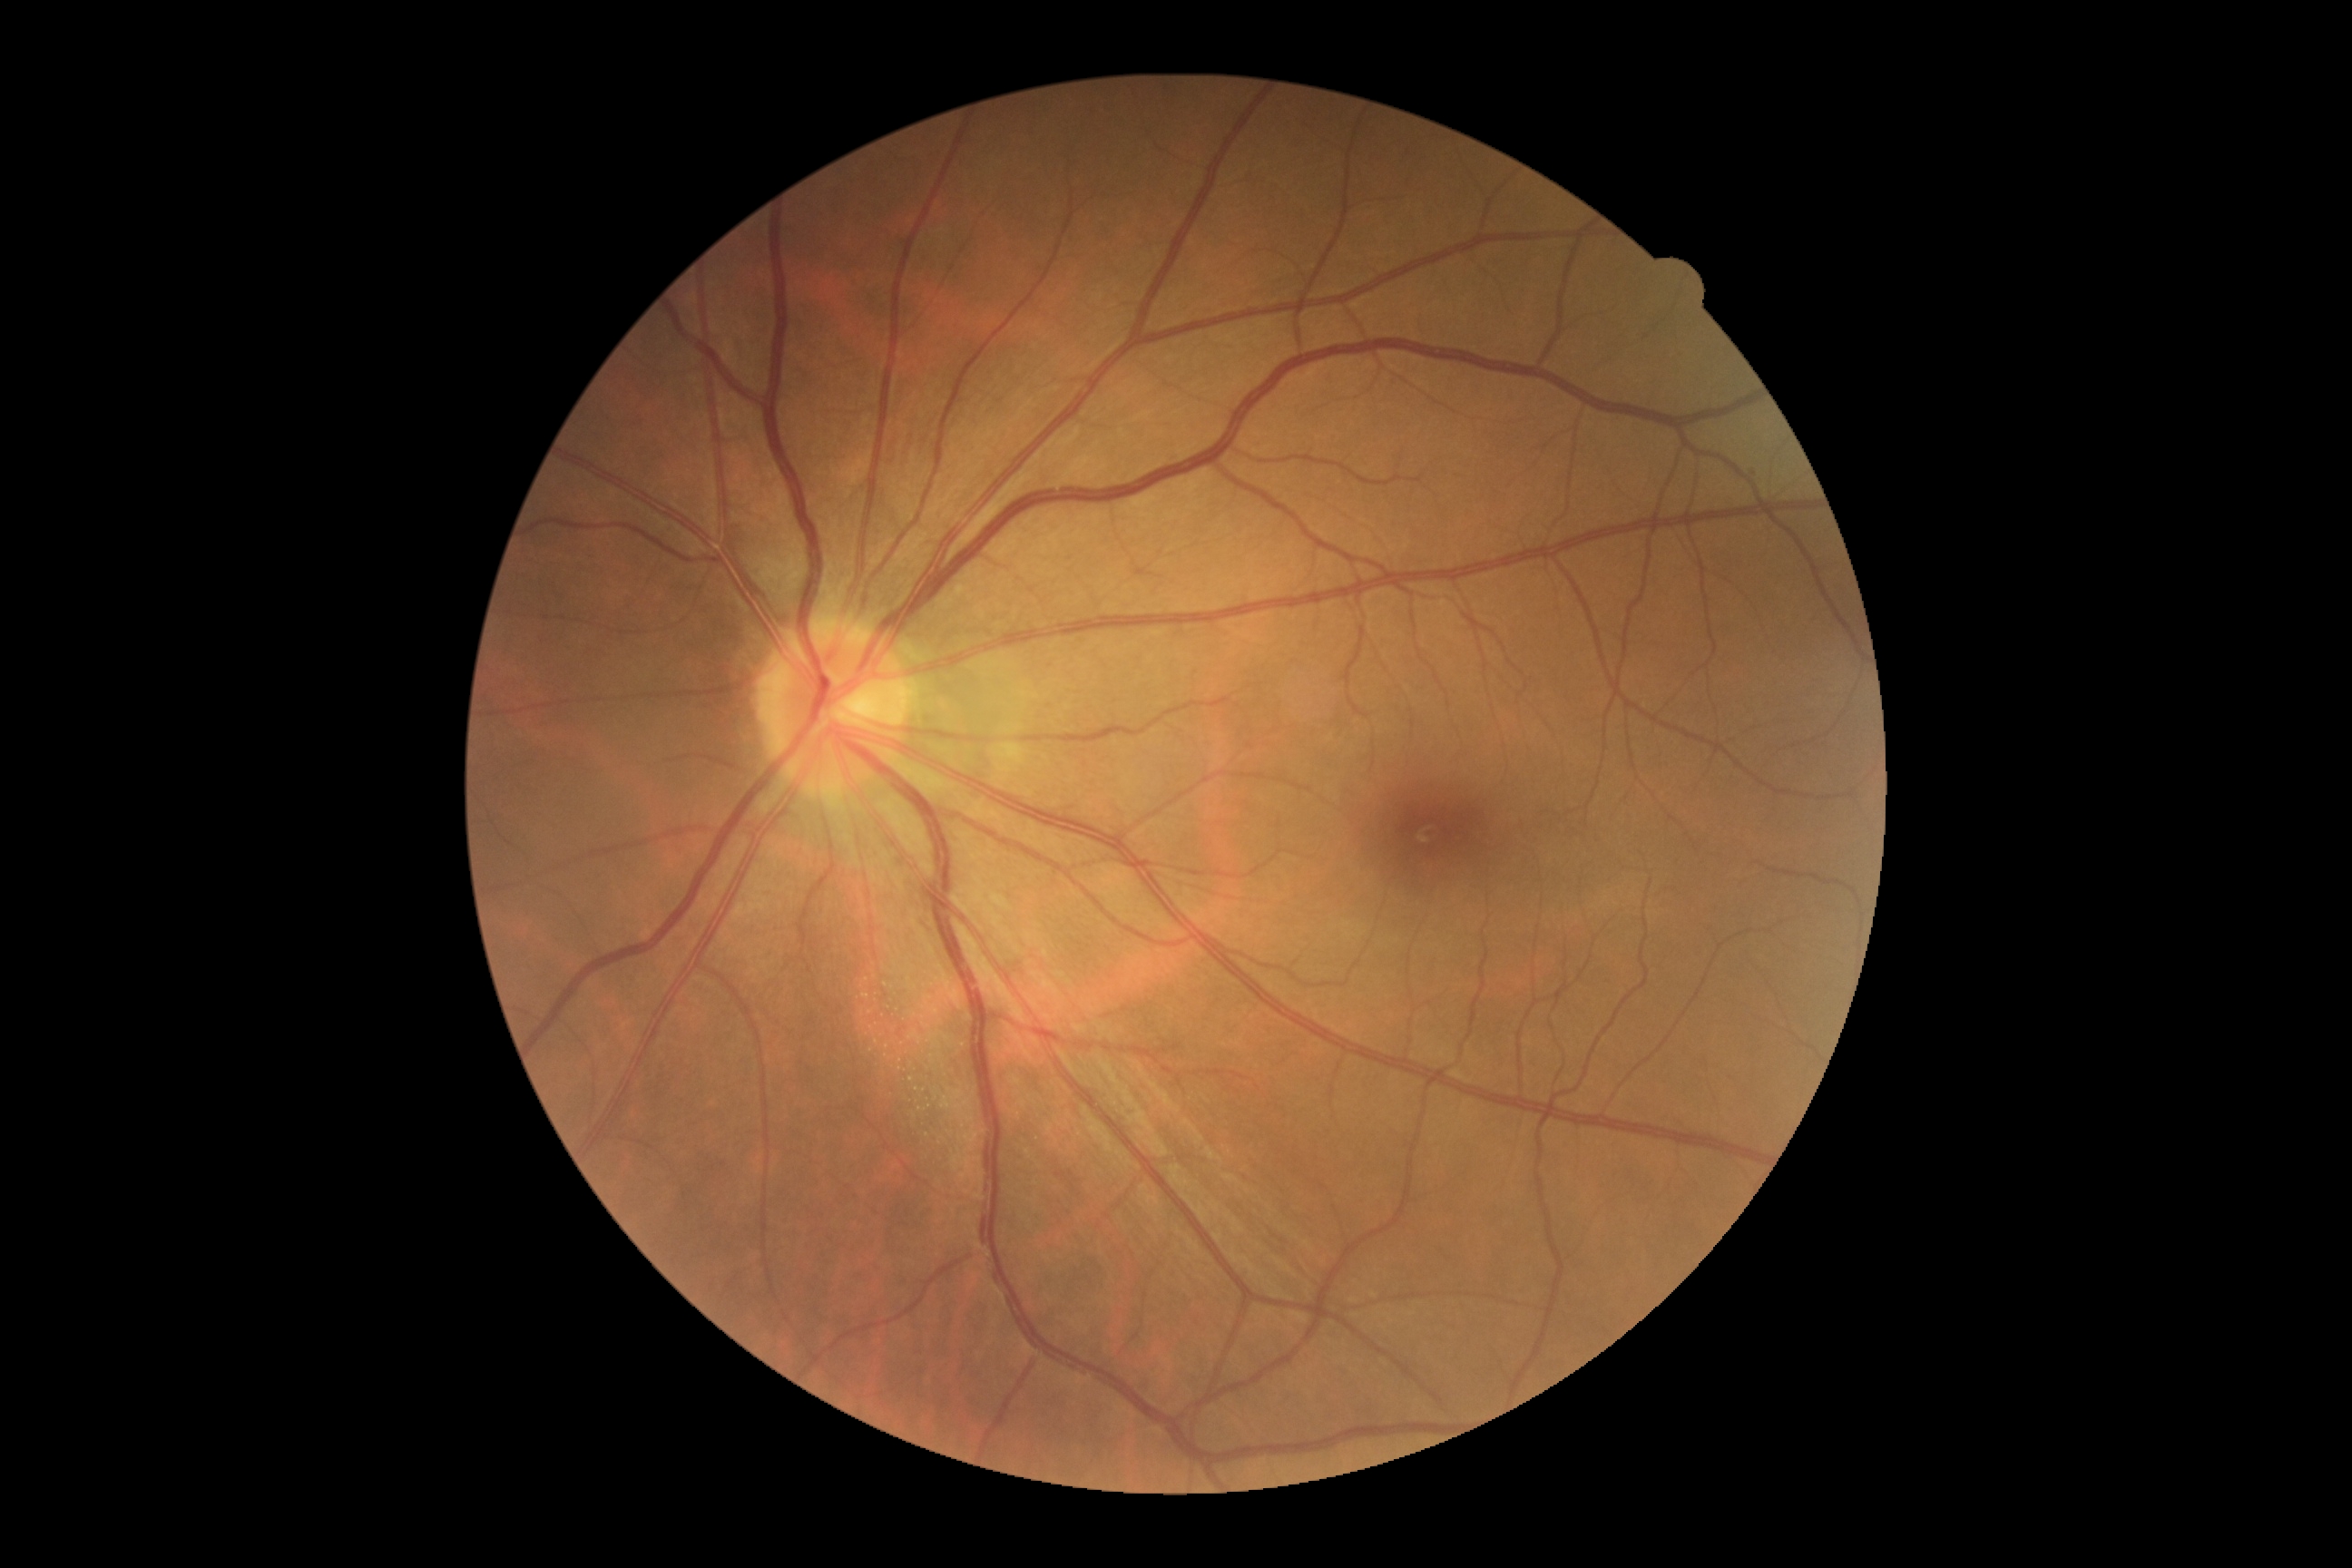 Findings:
– DR severity: 0